Wide-field fundus photograph of an infant · image size 1240x1240 · acquired on the Phoenix ICON:
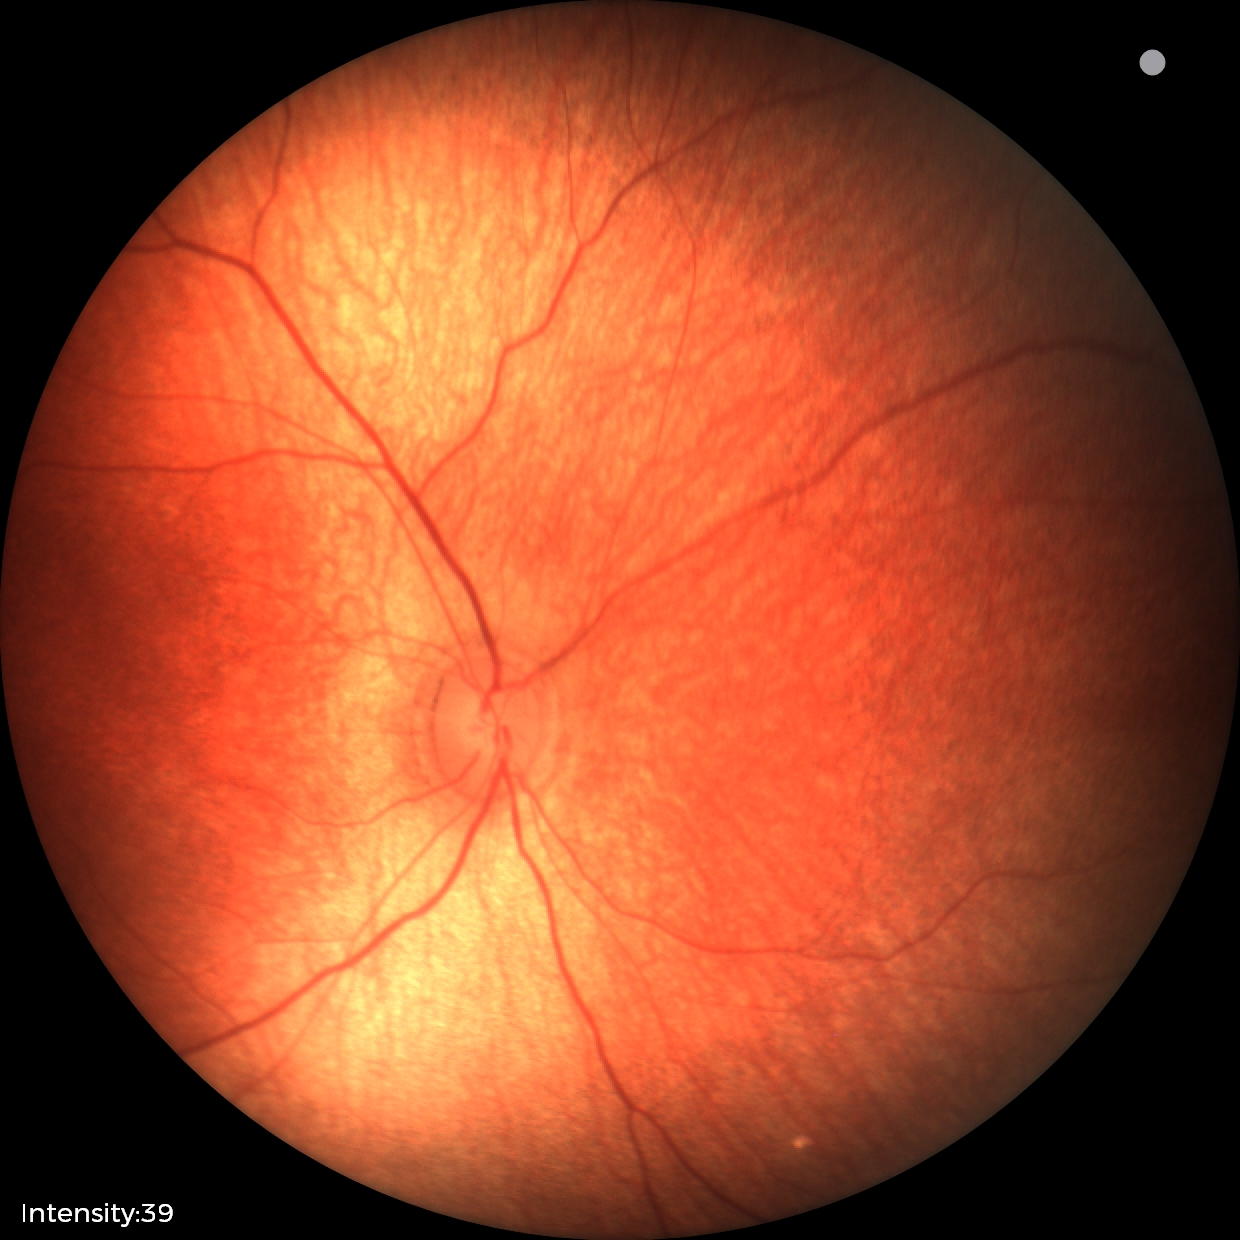

Impression: physiological finding.